NIDEK AFC-230 fundus camera — 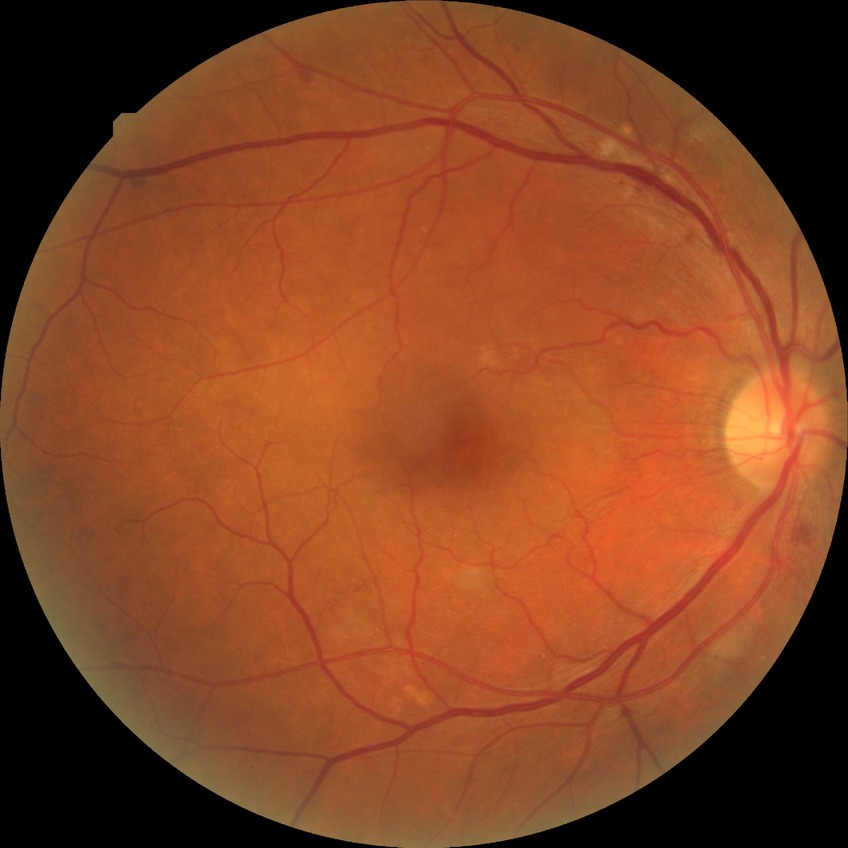
diabetic retinopathy severity = pre-proliferative diabetic retinopathy.